Phoenix ICON wide-field infant fundus image. 1240x1240.
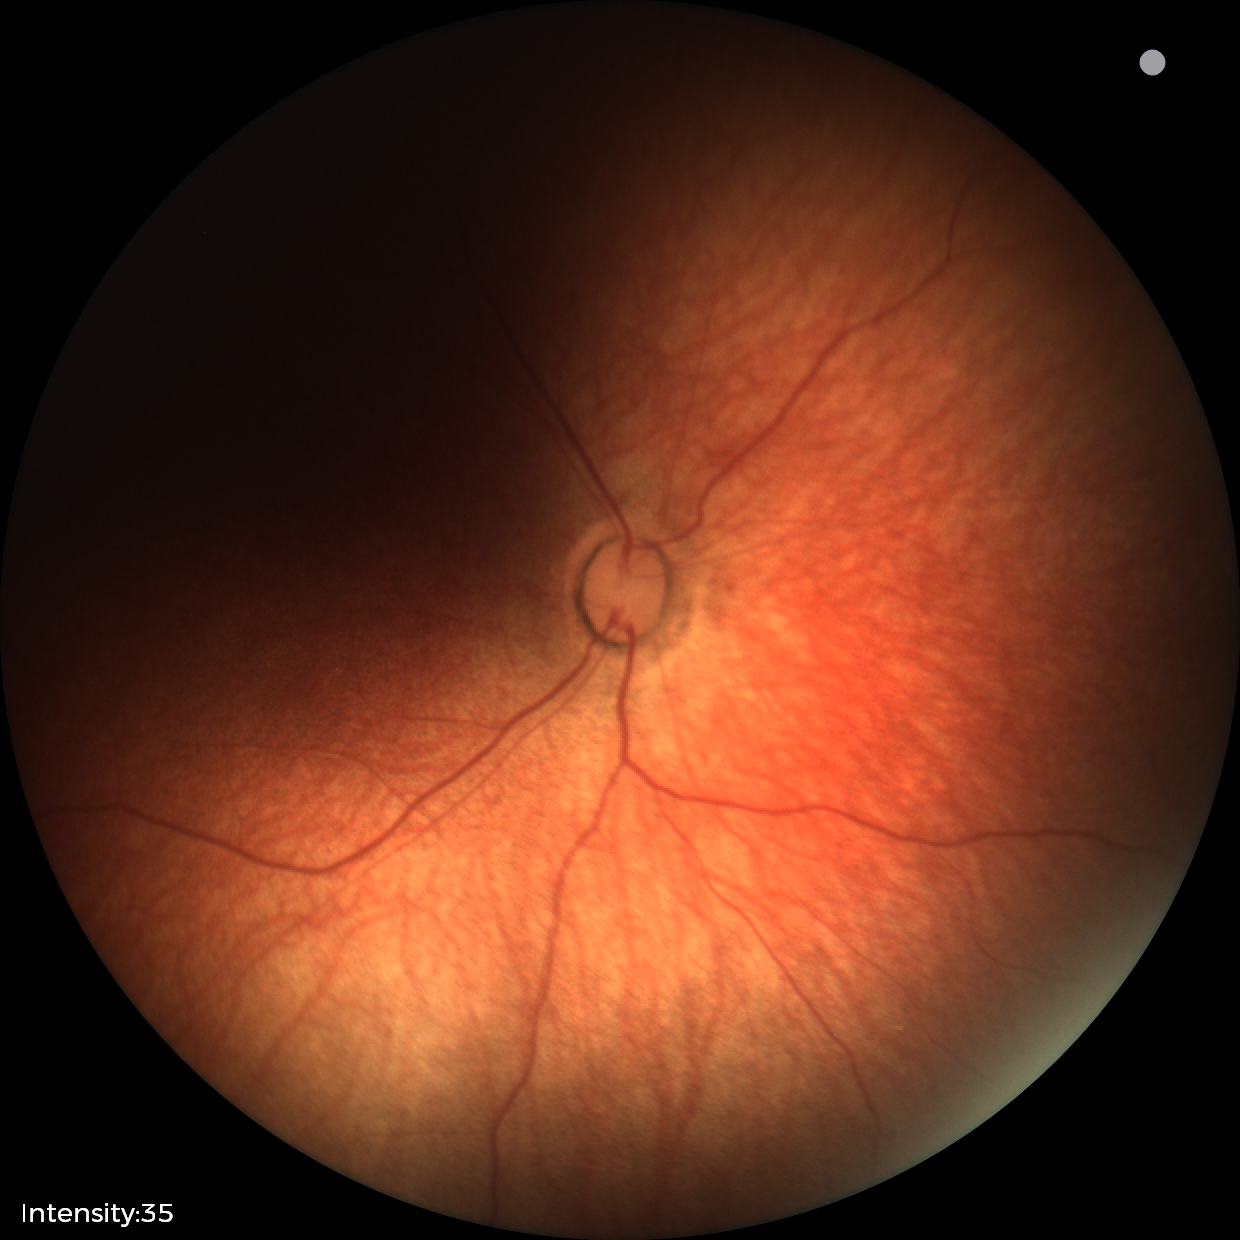
Examination with physiological retinal findings.